2048 by 1536 pixels; 45-degree field of view: 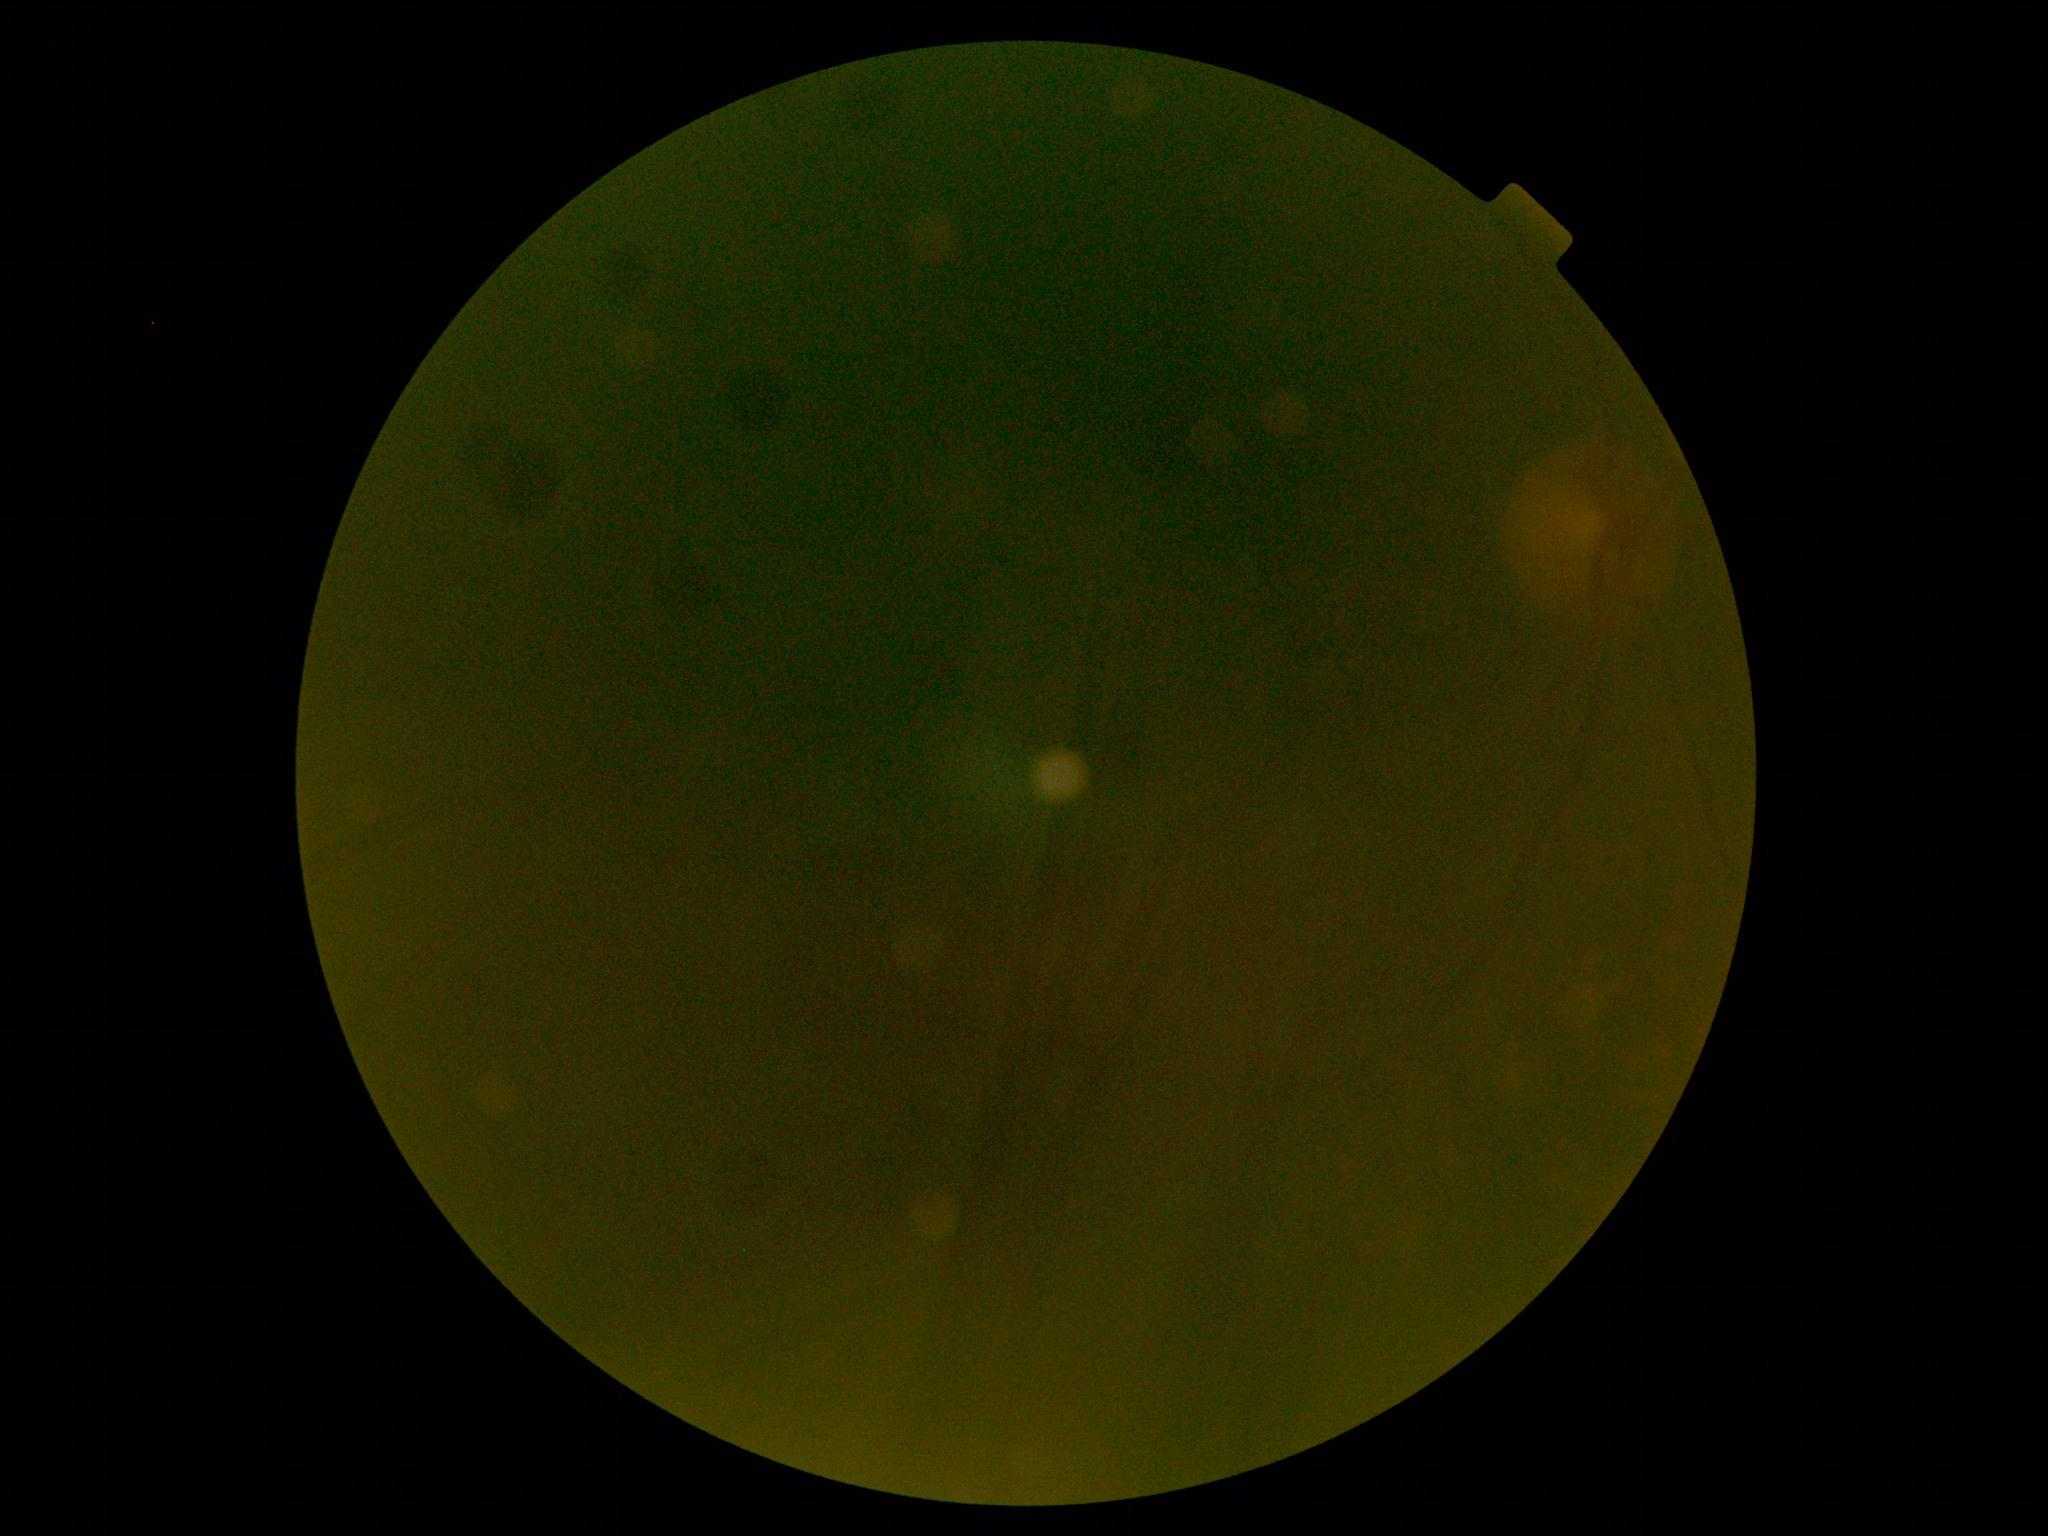 image quality: insufficient for DR assessment | diabetic retinopathy (DR): ungradable.